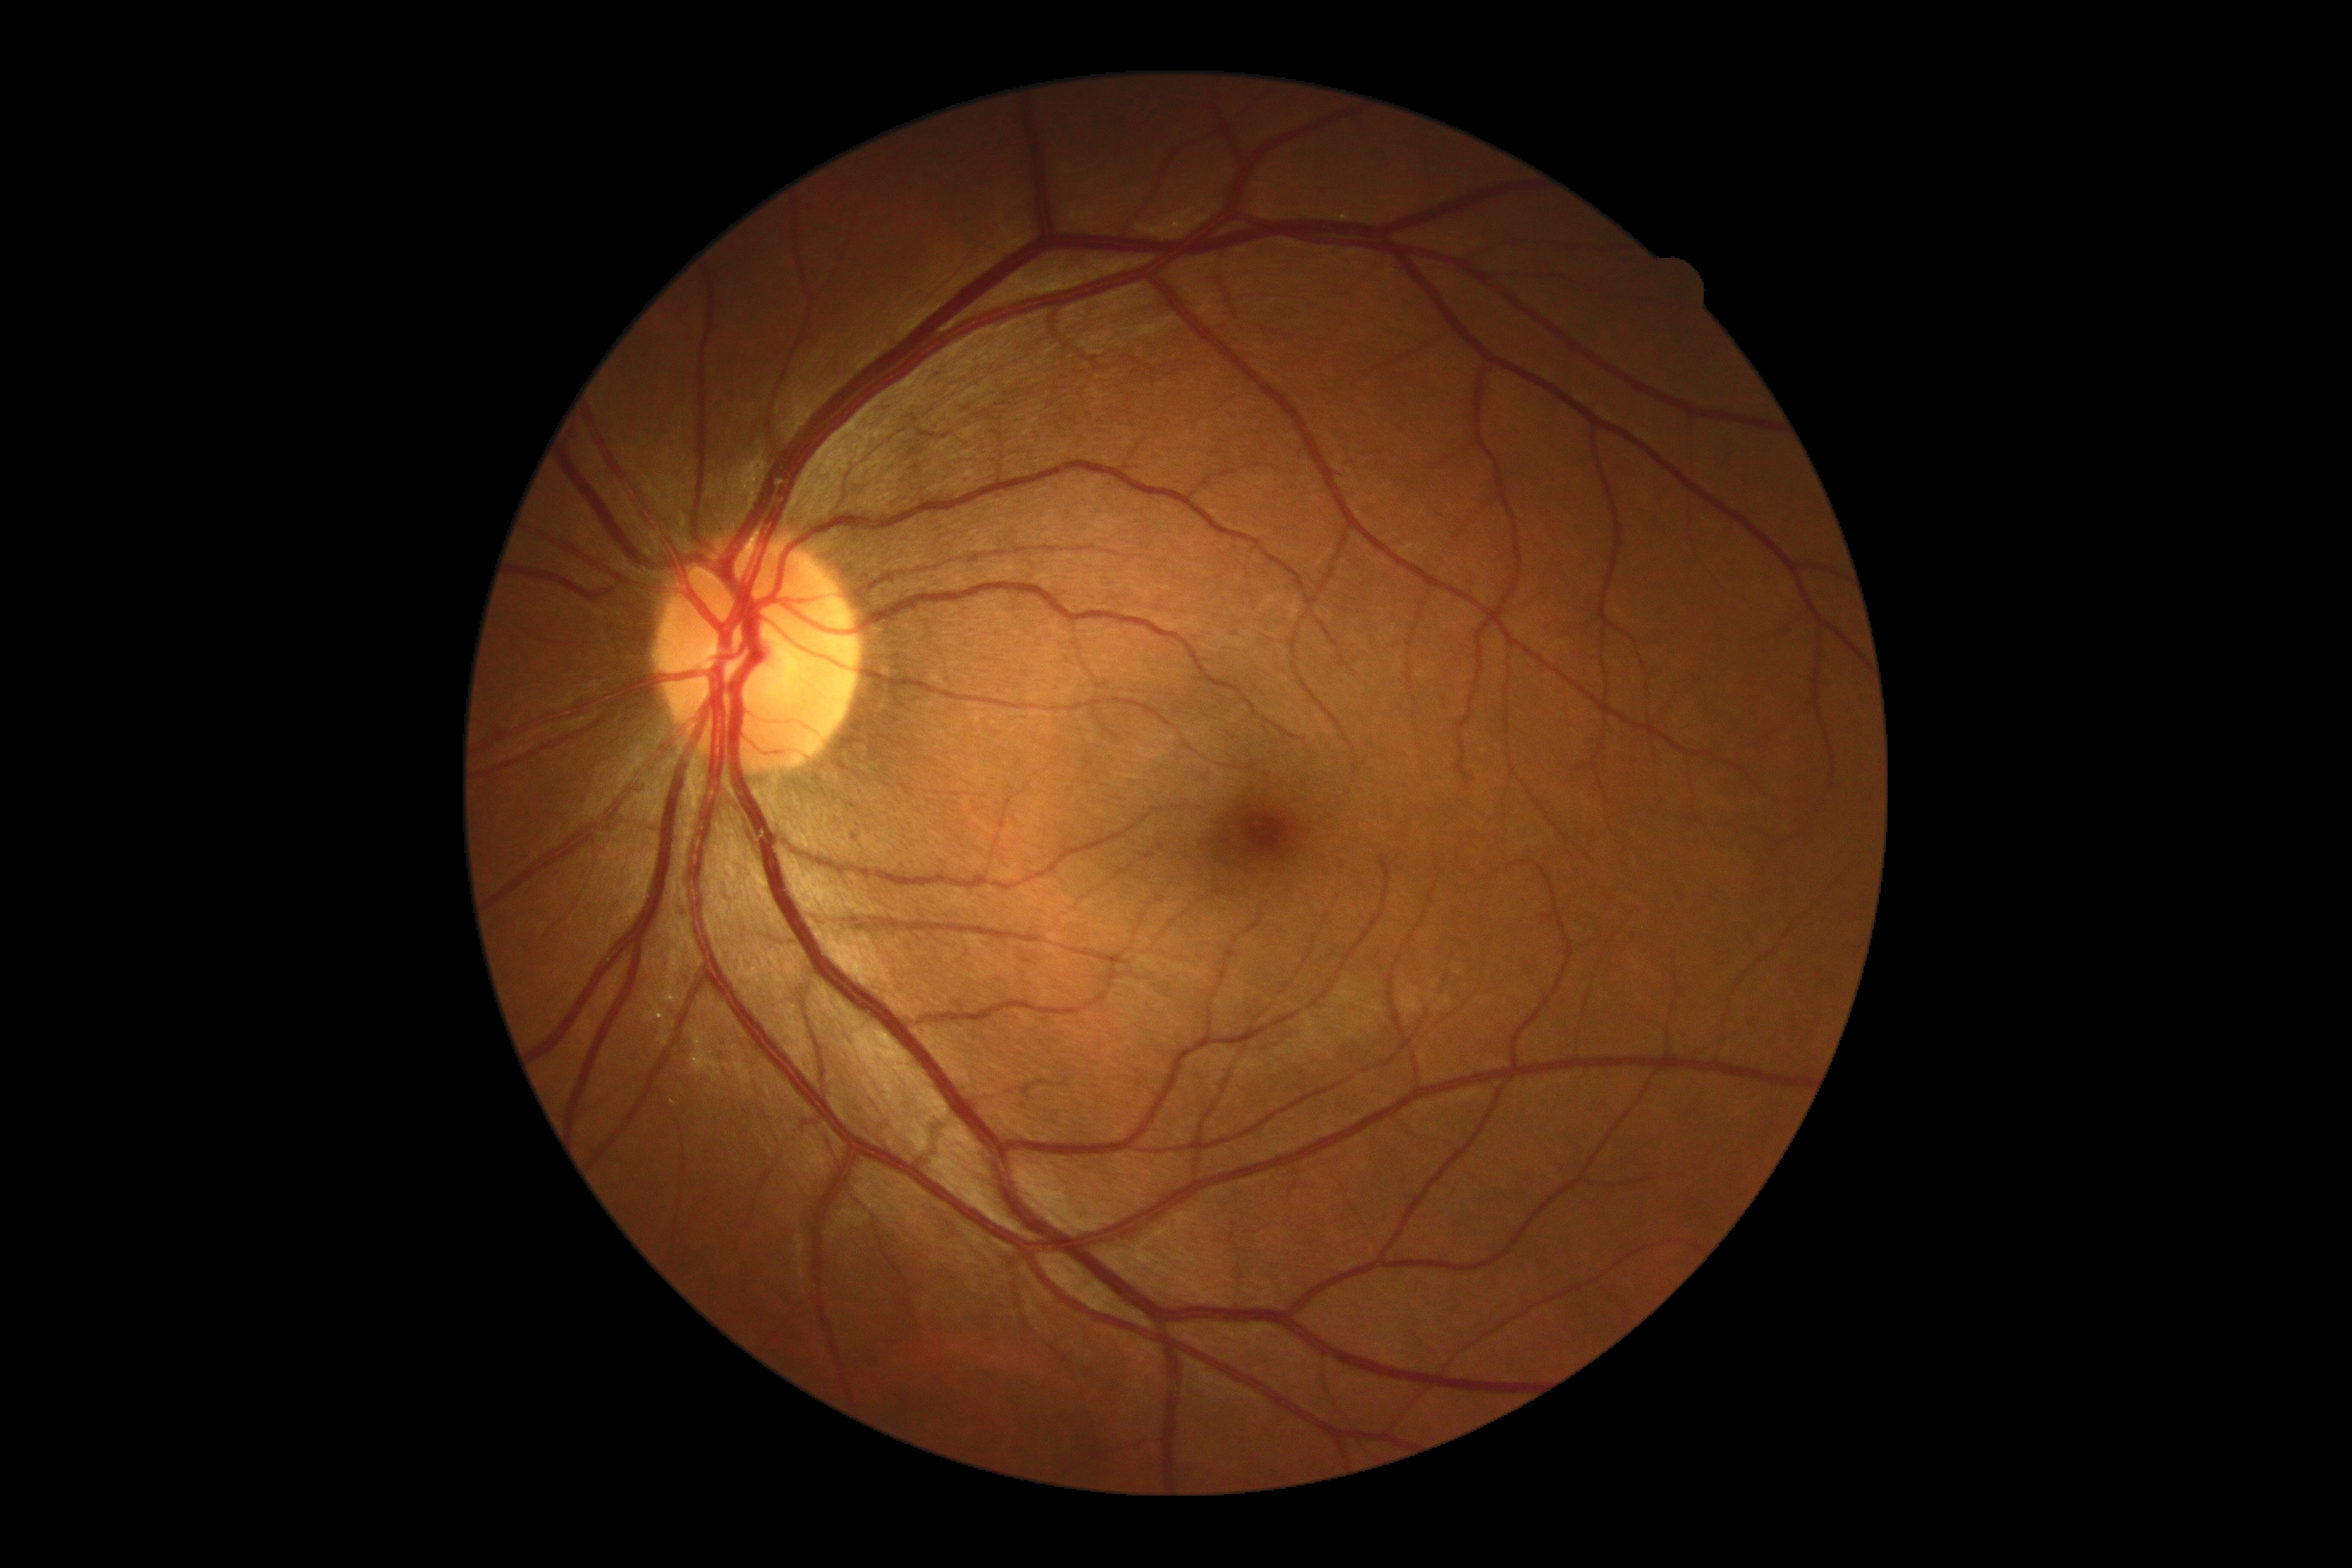 diabetic retinopathy (DR): no apparent diabetic retinopathy (grade 0); DR impression: no apparent DR.